Cropped to the optic nerve head — 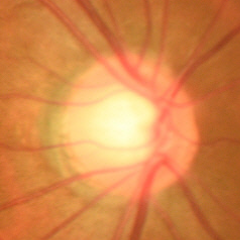

Optic disc appearance consistent with early glaucoma.